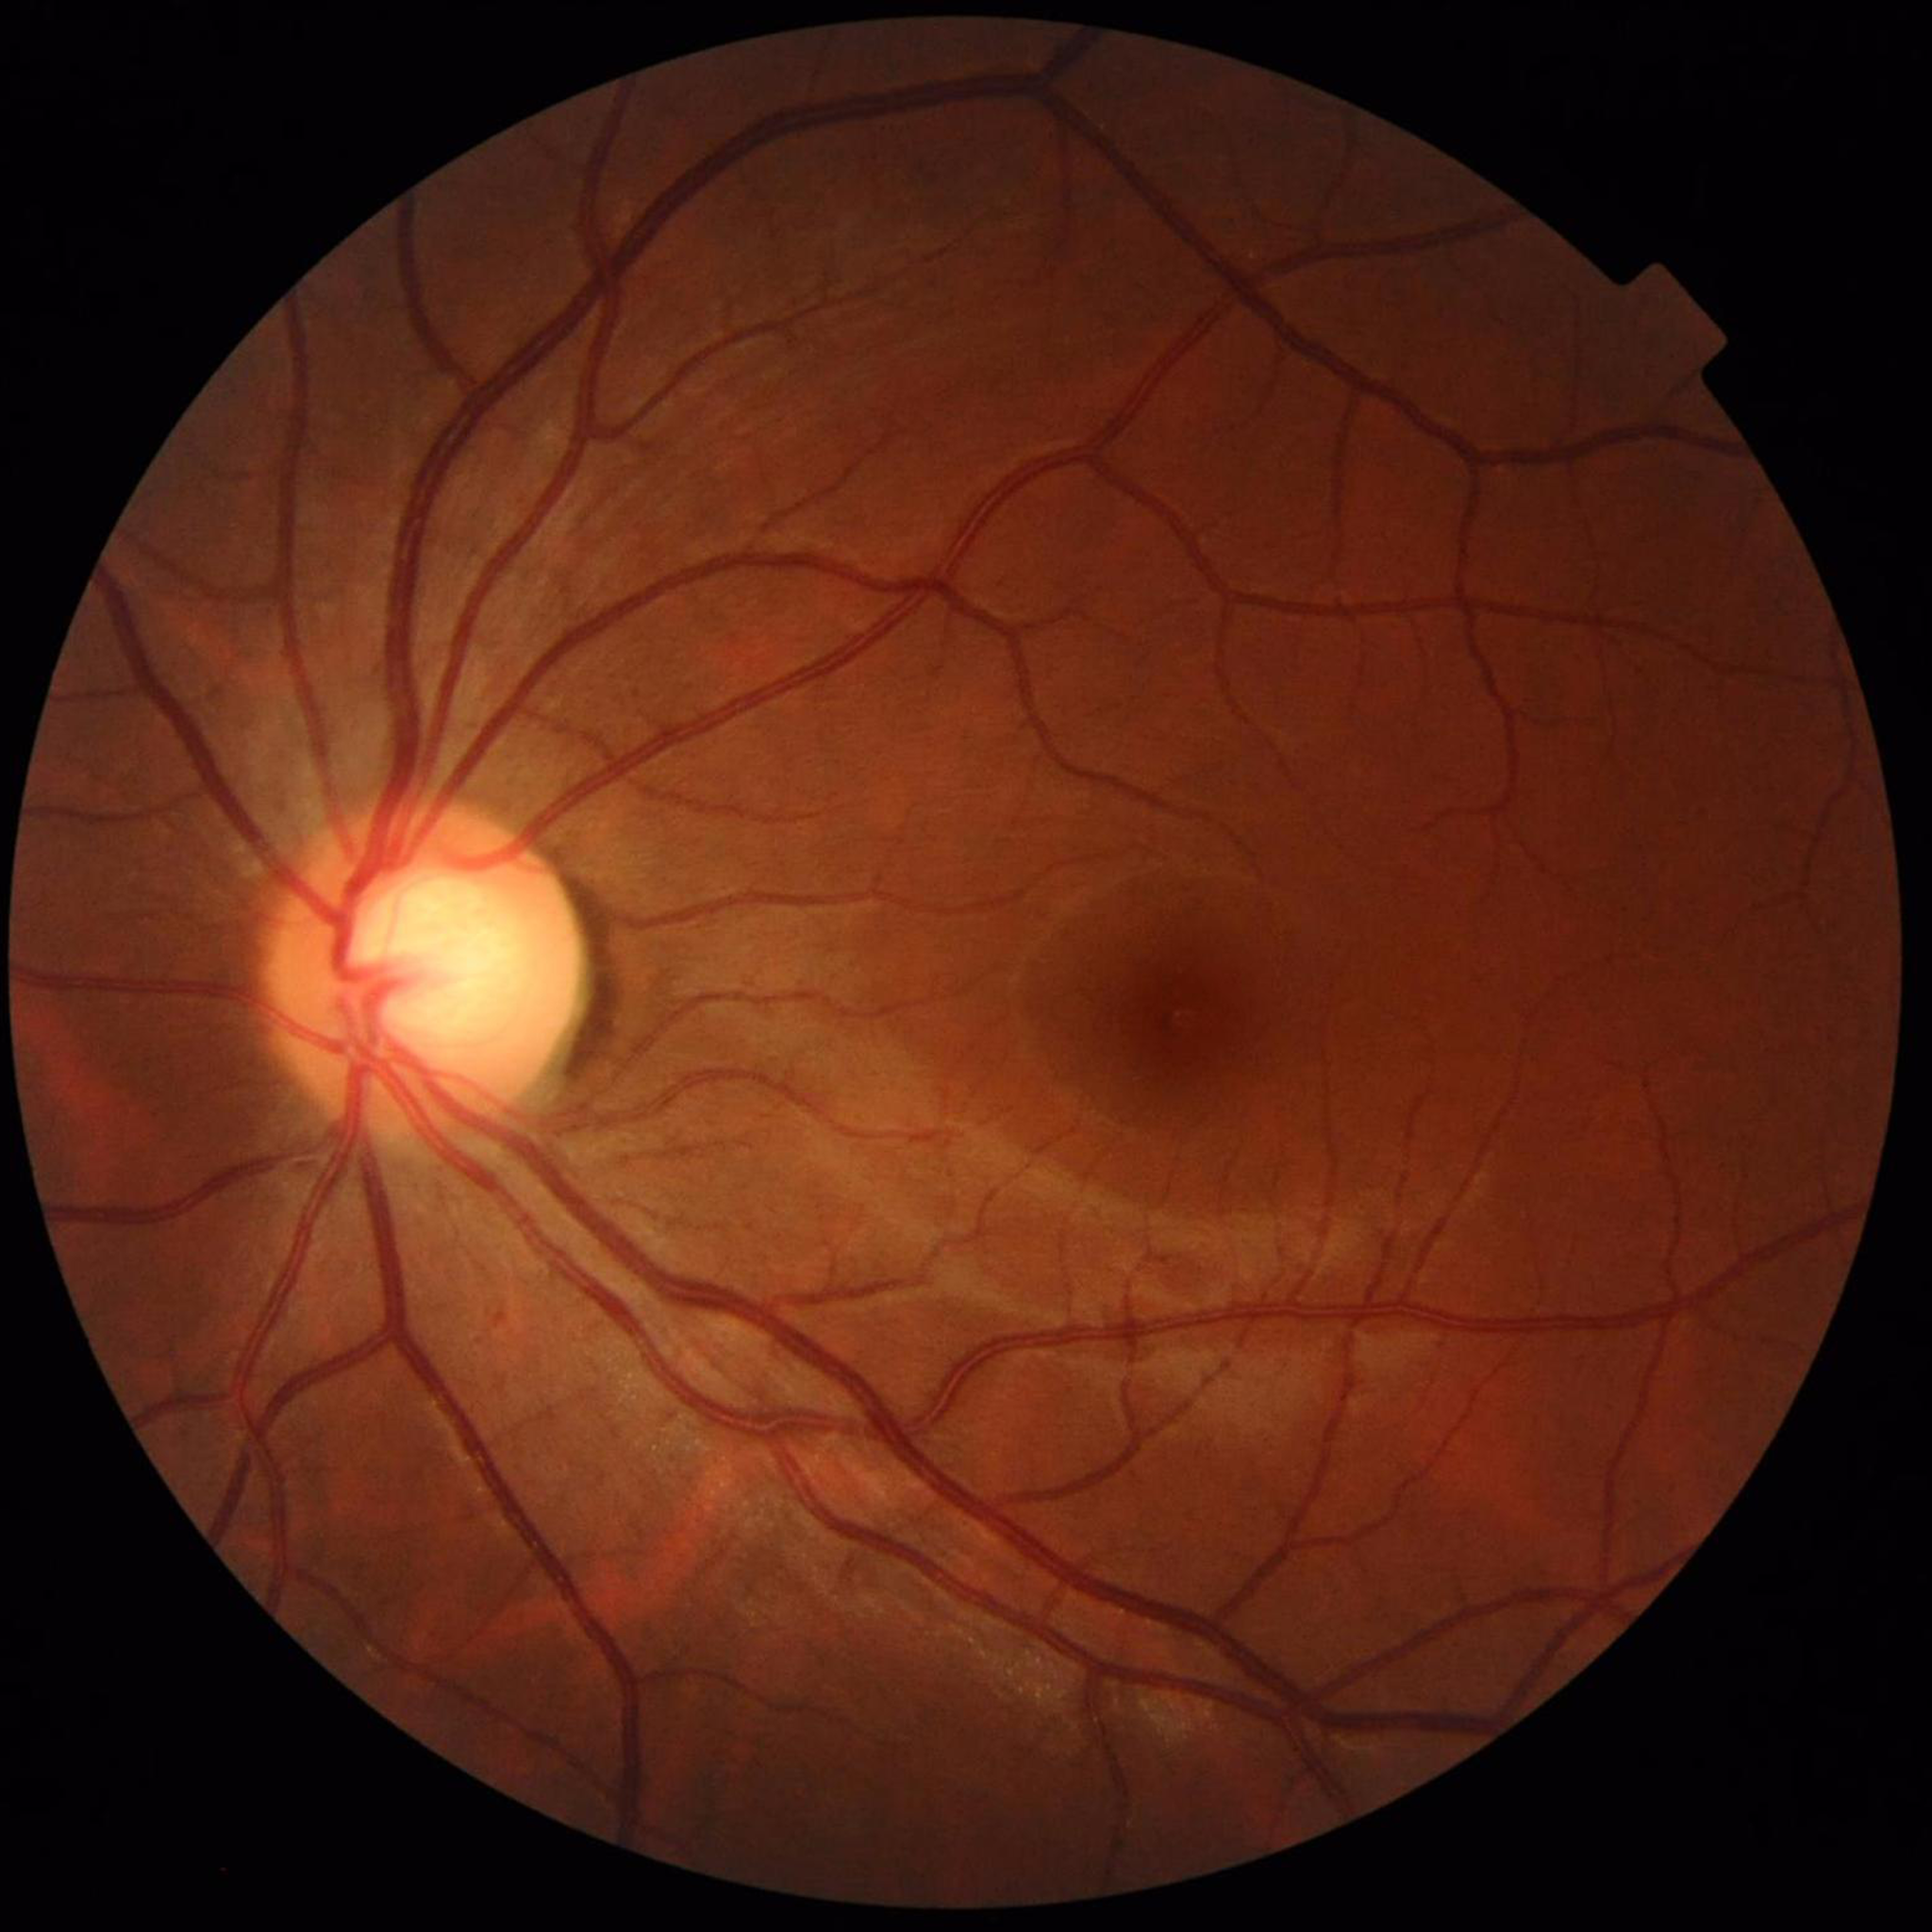

  diagnosis: glaucoma